FOV: 45 degrees — 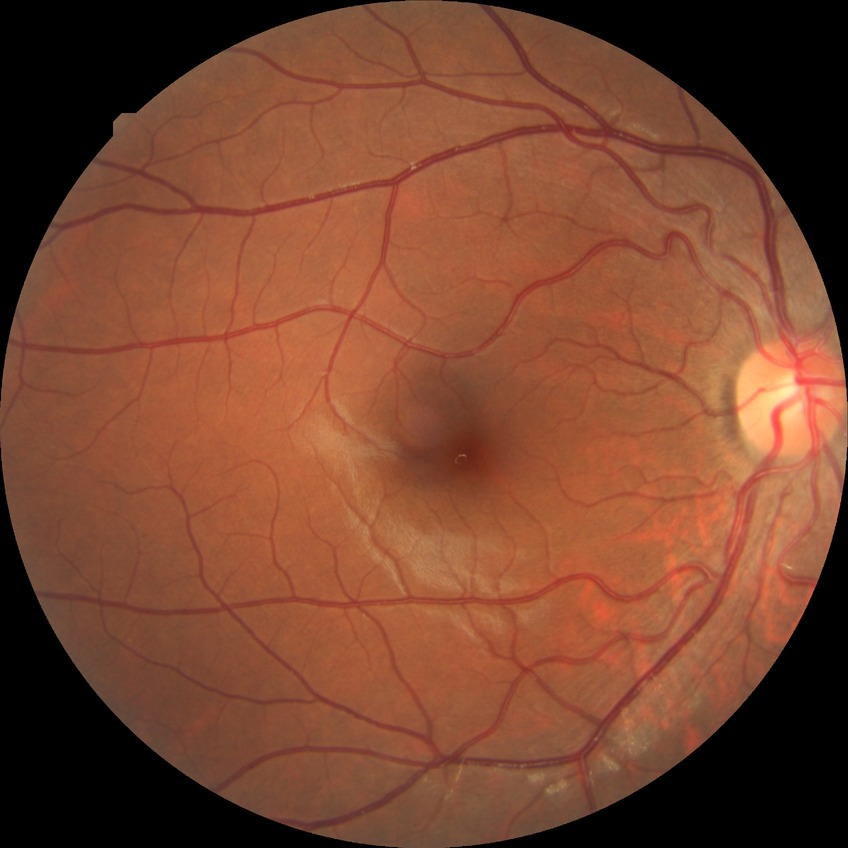
{
  "davis_grade": "no diabetic retinopathy"
}